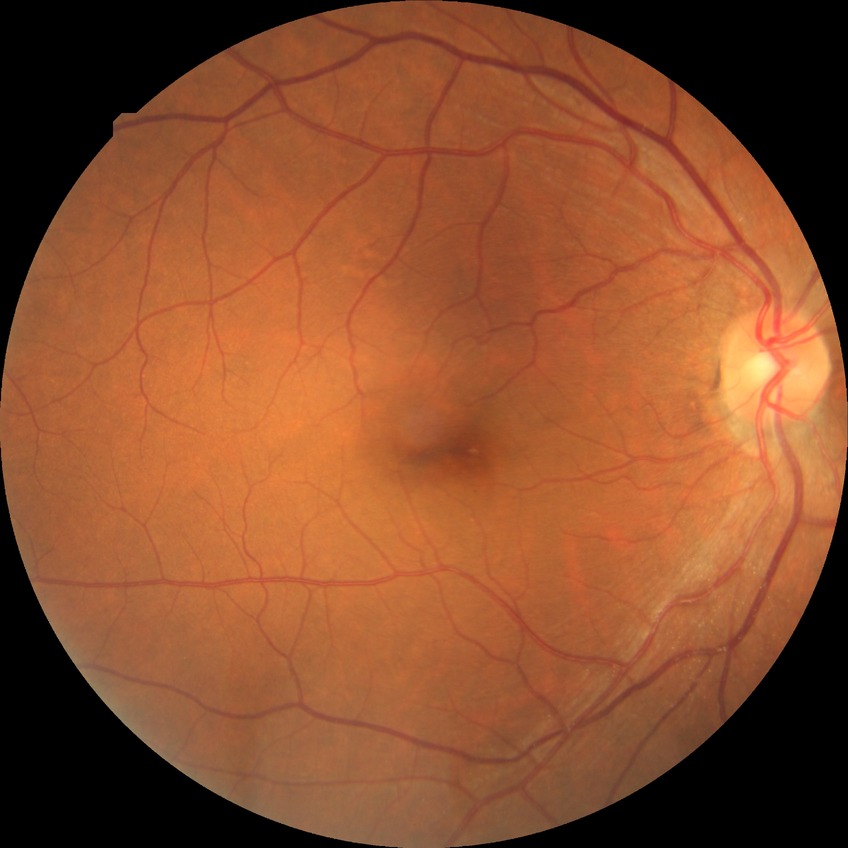 retinopathy grade = simple diabetic retinopathy.